Pediatric retinal photograph (wide-field). Image size 1440x1080. Captured with the Natus RetCam Envision (130° field of view) — 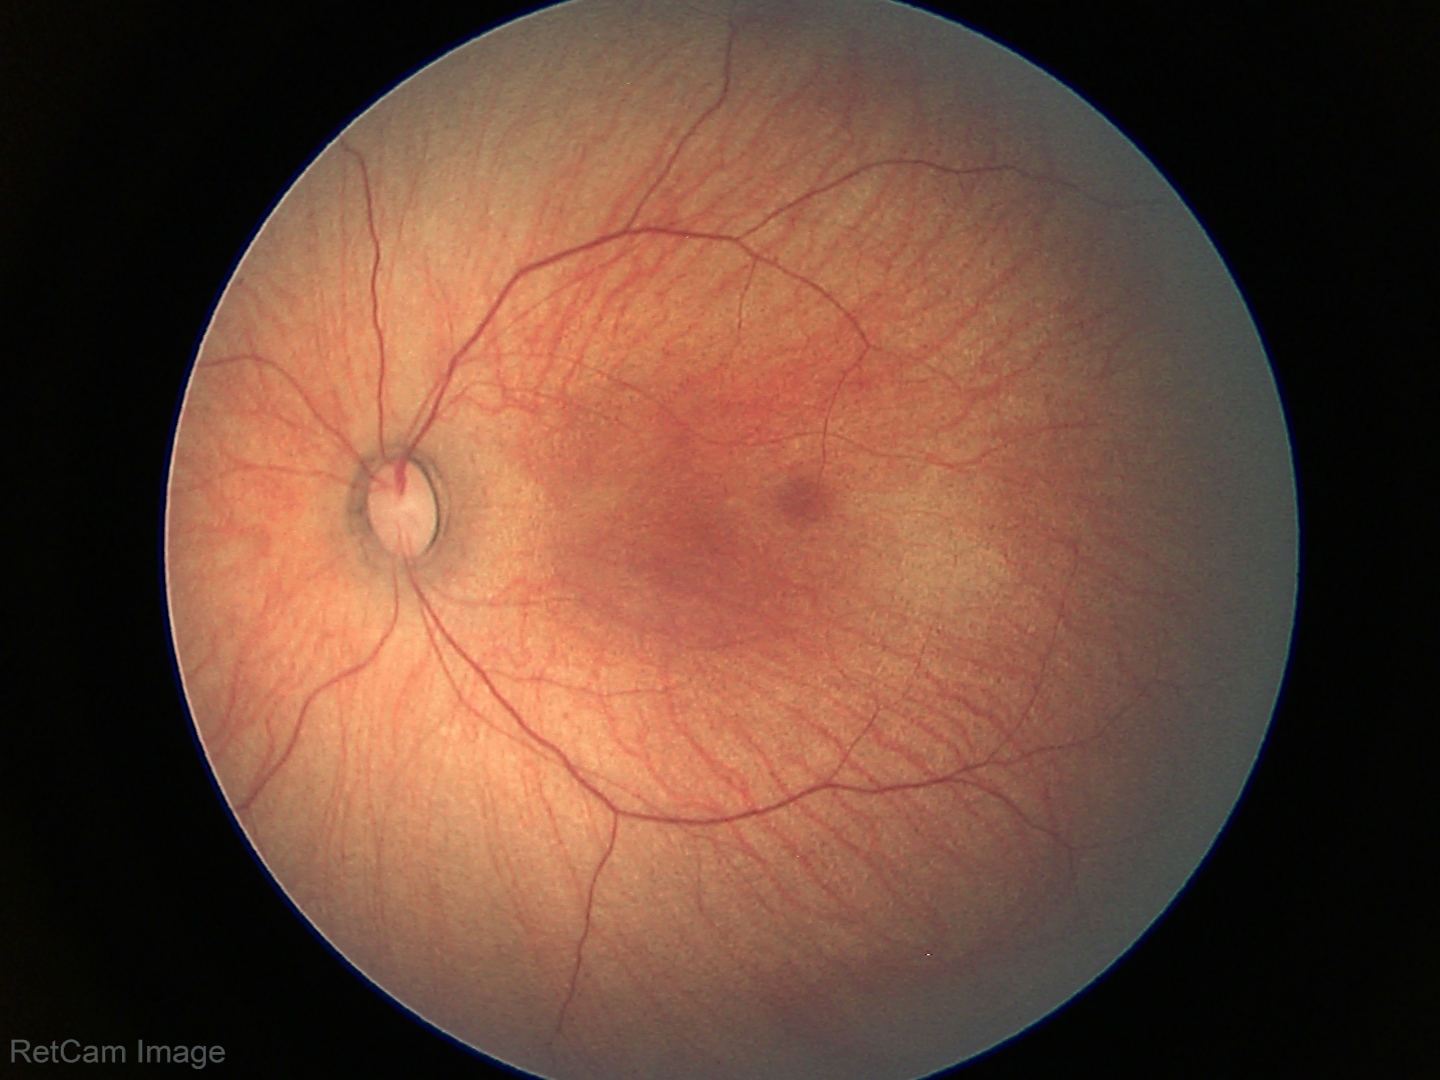 Normal screening examination.